Wide-field contact fundus photograph of an infant:
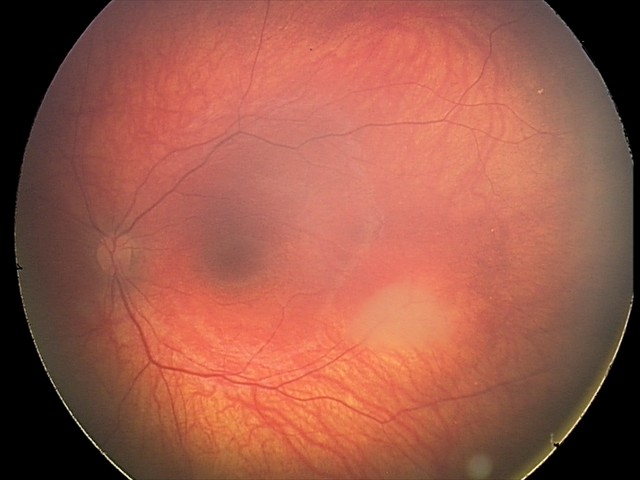

From an examination with diagnosis of retinal astrocytic hamartoma.